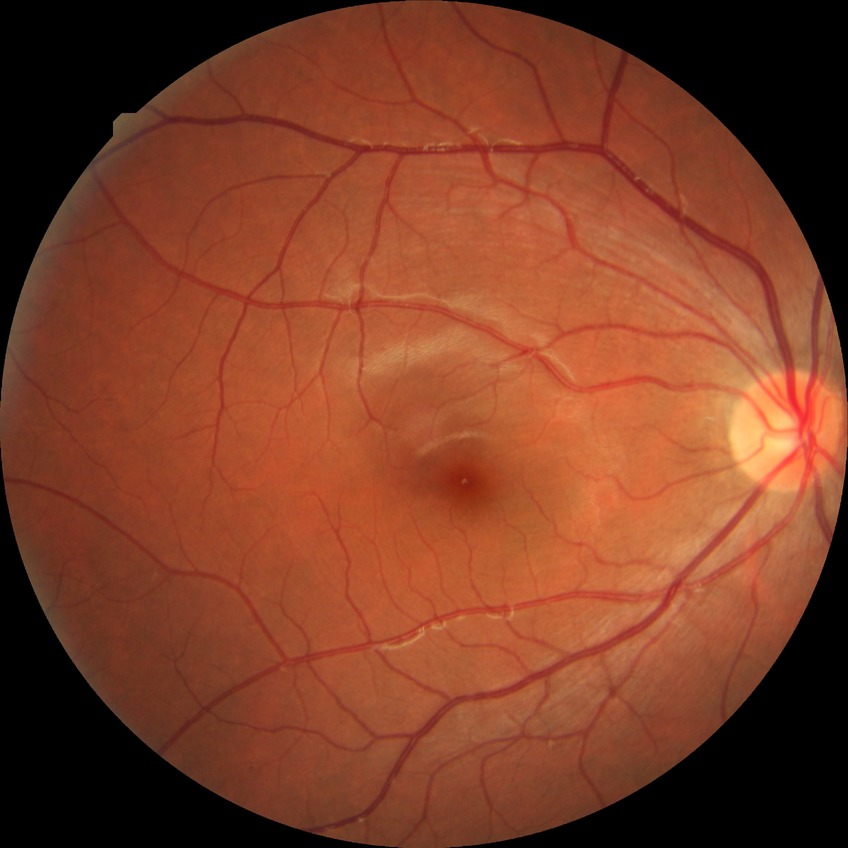 Diabetic retinopathy (DR): NDR (no diabetic retinopathy).